Fundus photo
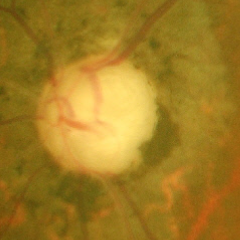
Glaucomatous optic neuropathy is present. Glaucoma status = severe glaucomatous damage.